2352 by 1568 pixels; 45° field of view; fundus photo: 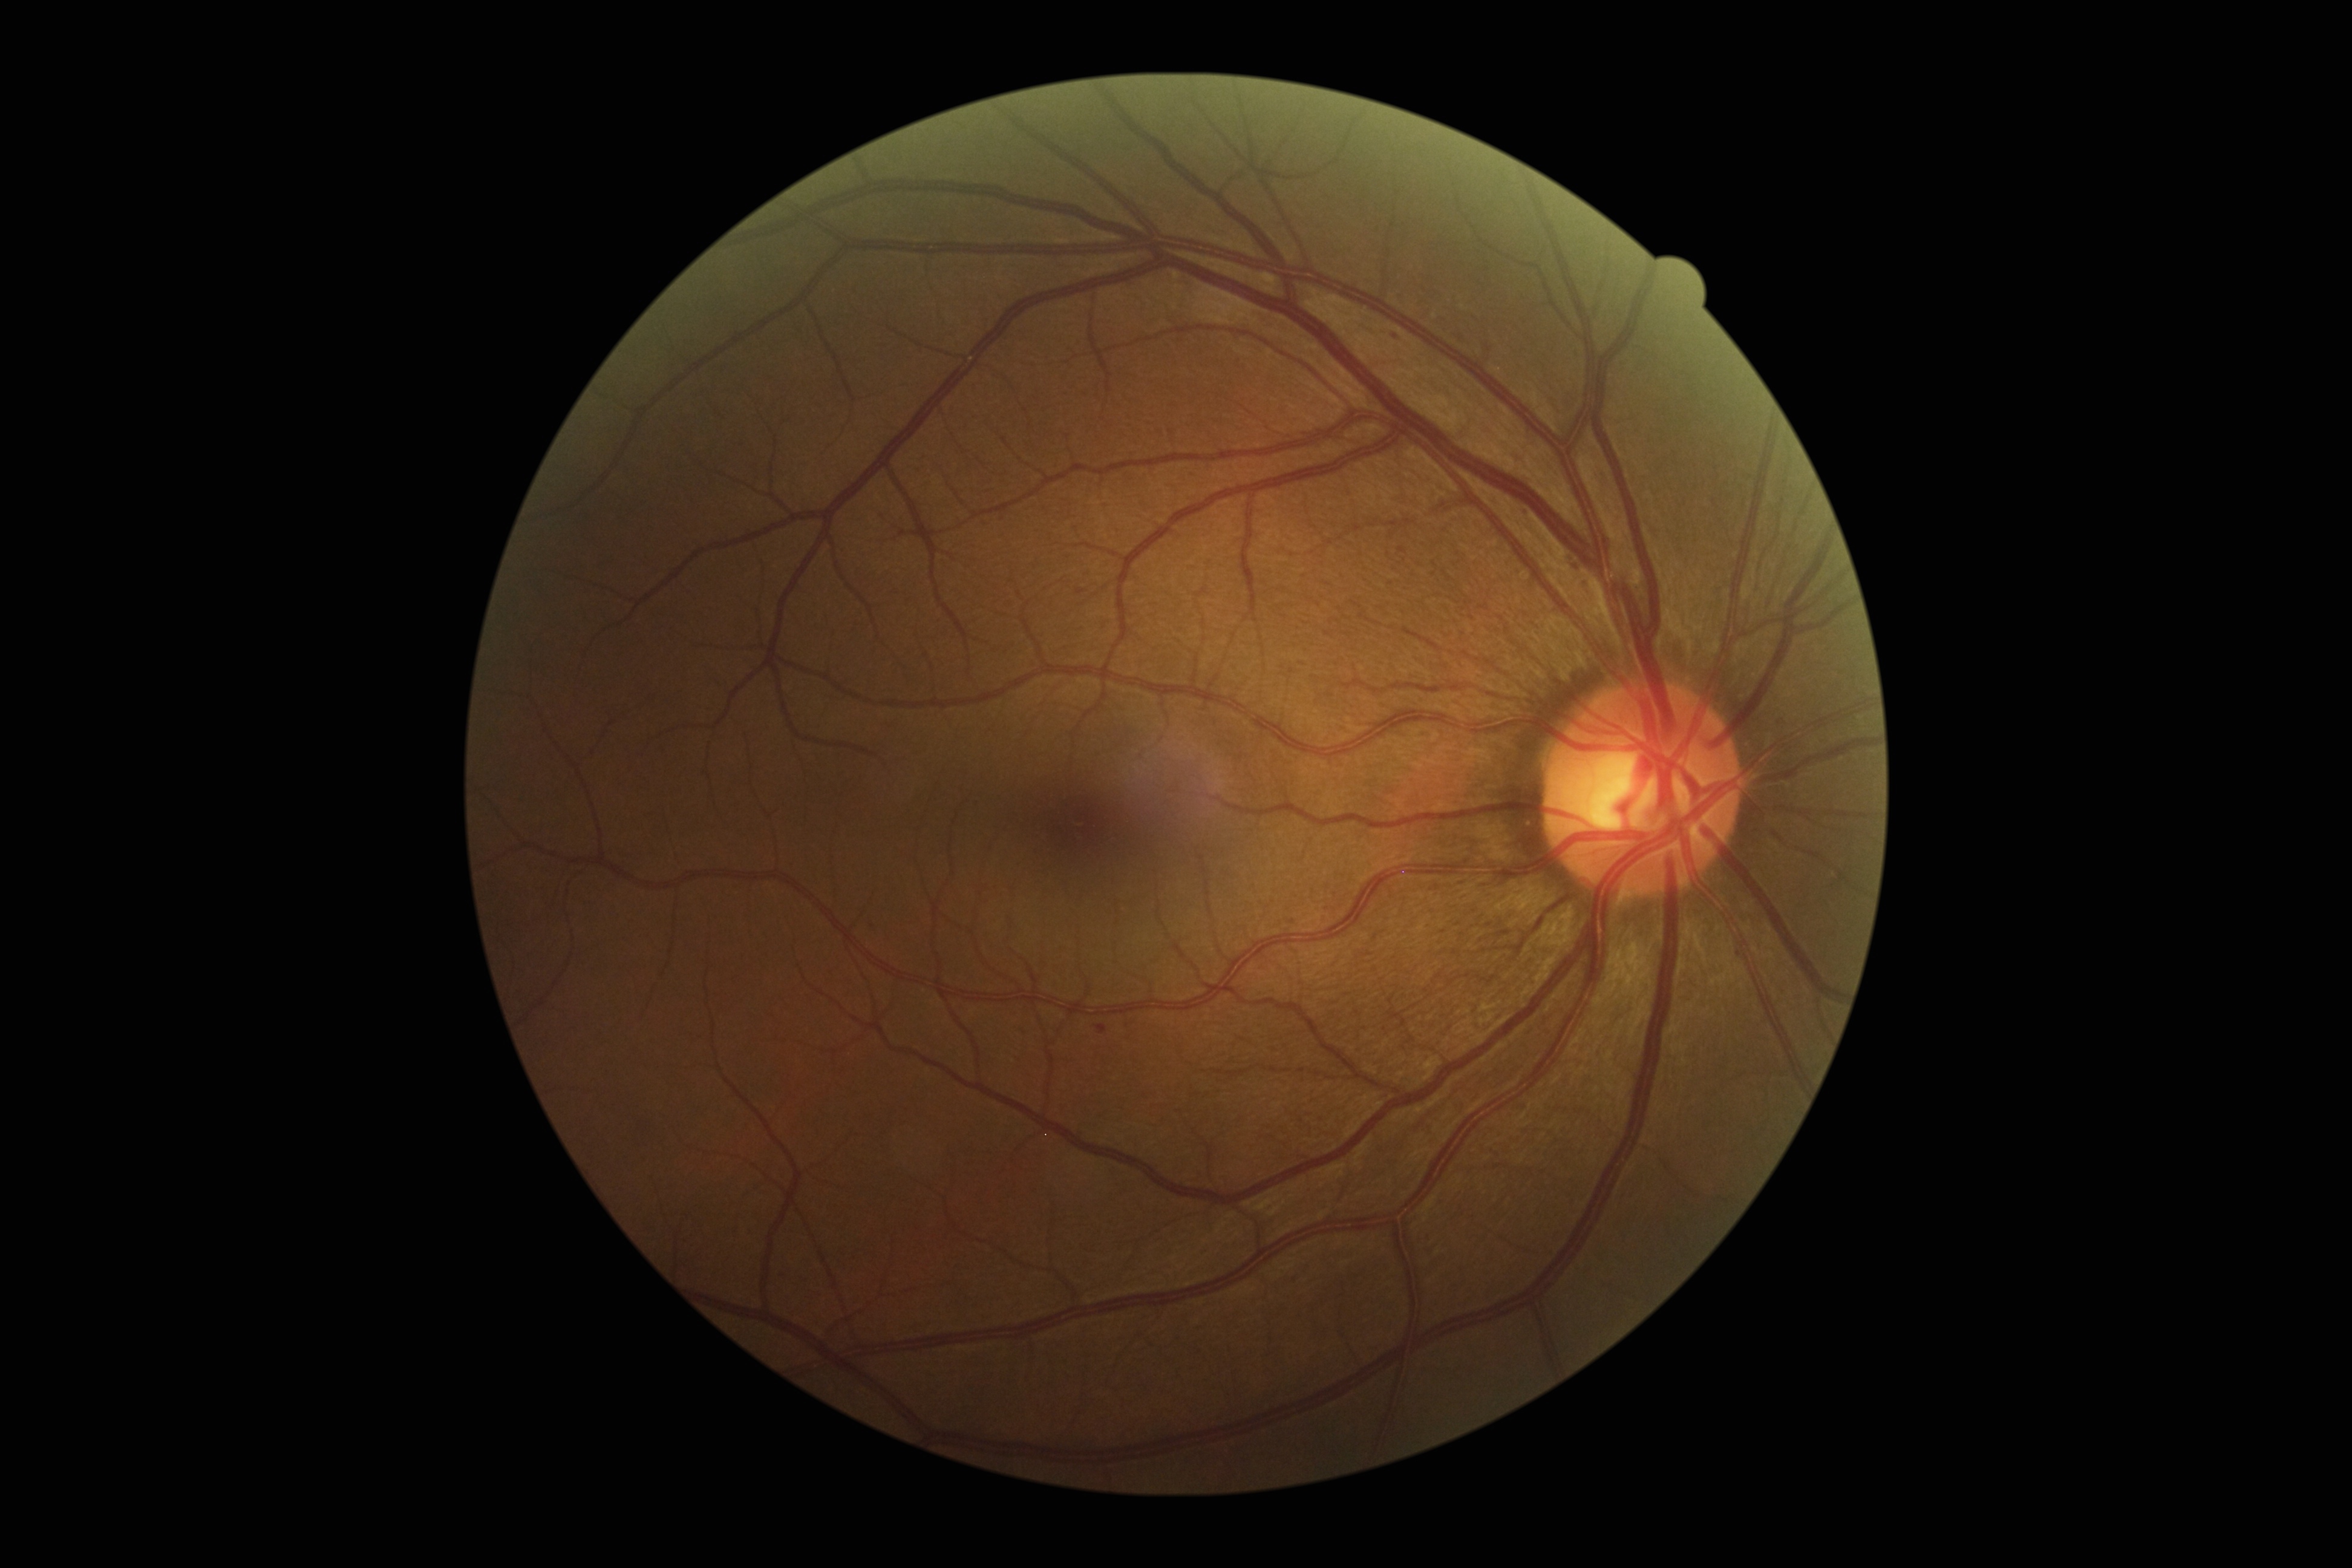 Diabetic retinopathy: grade 1. Hemorrhages found at box(1097, 1024, 1108, 1034). Microaneurysms found at box(1521, 509, 1531, 517); box(1582, 583, 1590, 590); box(1779, 720, 1788, 728); box(1391, 332, 1403, 342). Additional small microaneurysms near 1739/954. No soft exudates identified. No hard exudates identified.